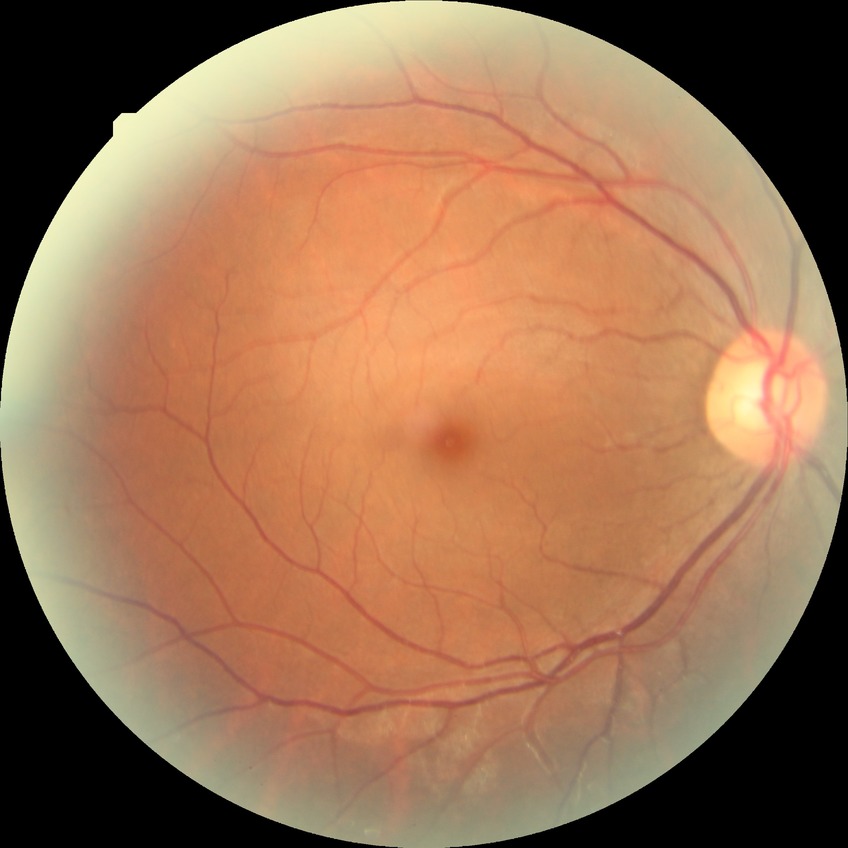
Diabetic retinopathy grade: no diabetic retinopathy.